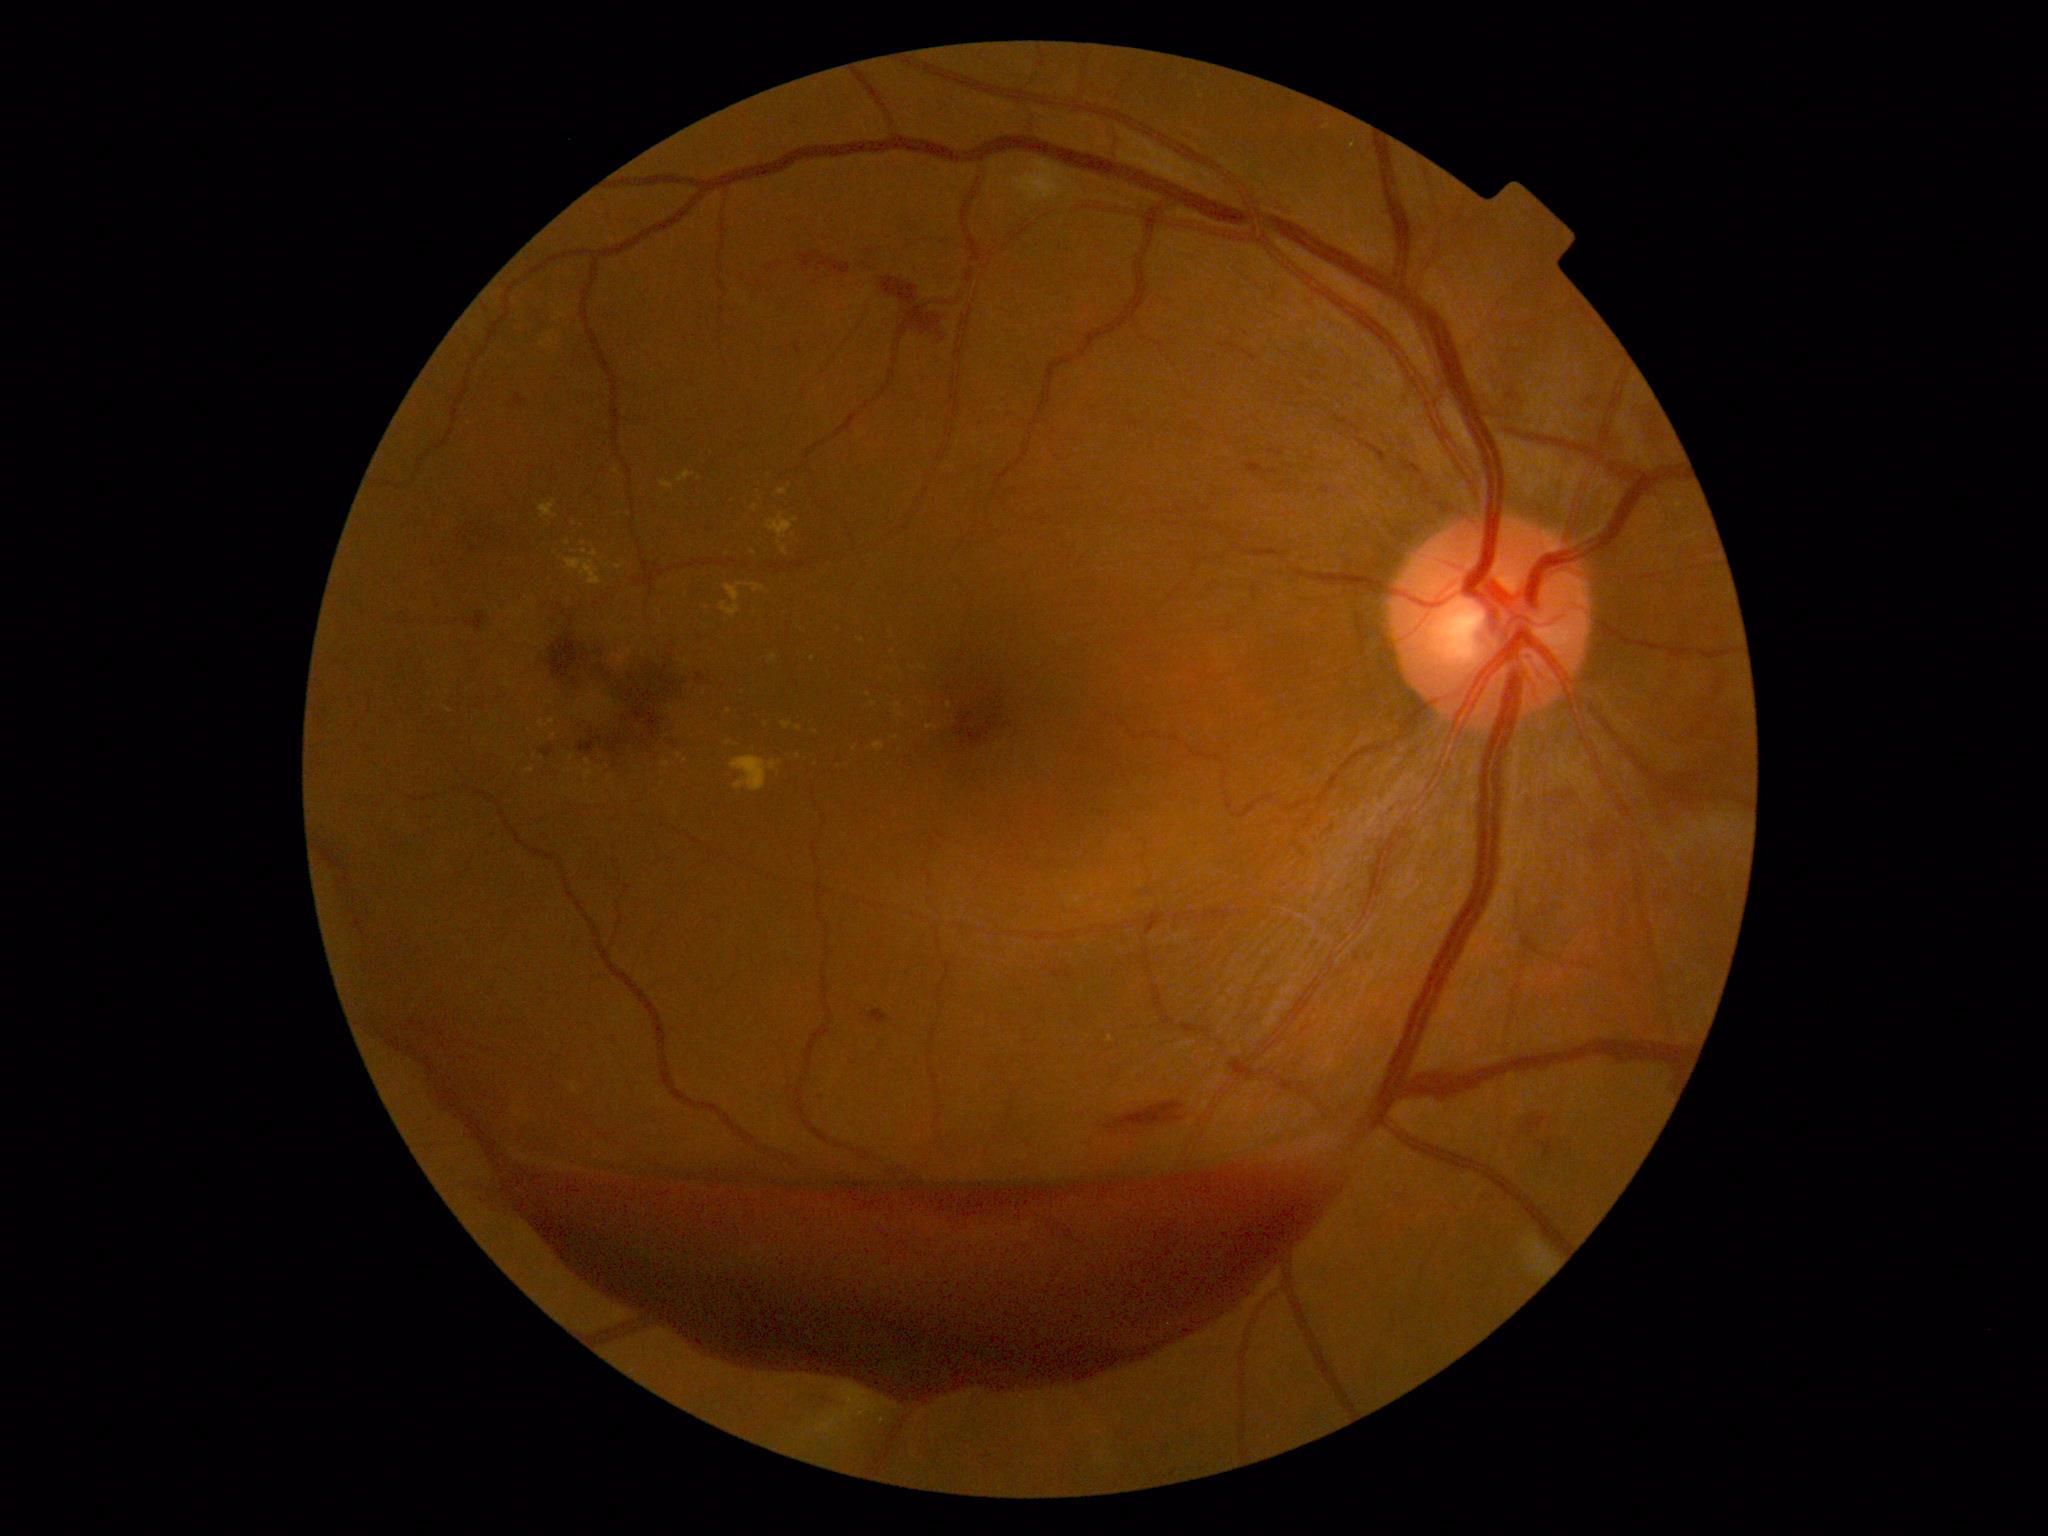
Retinopathy grade: proliferative diabetic retinopathy (4).